Graded on the modified Davis scale · 45-degree field of view:
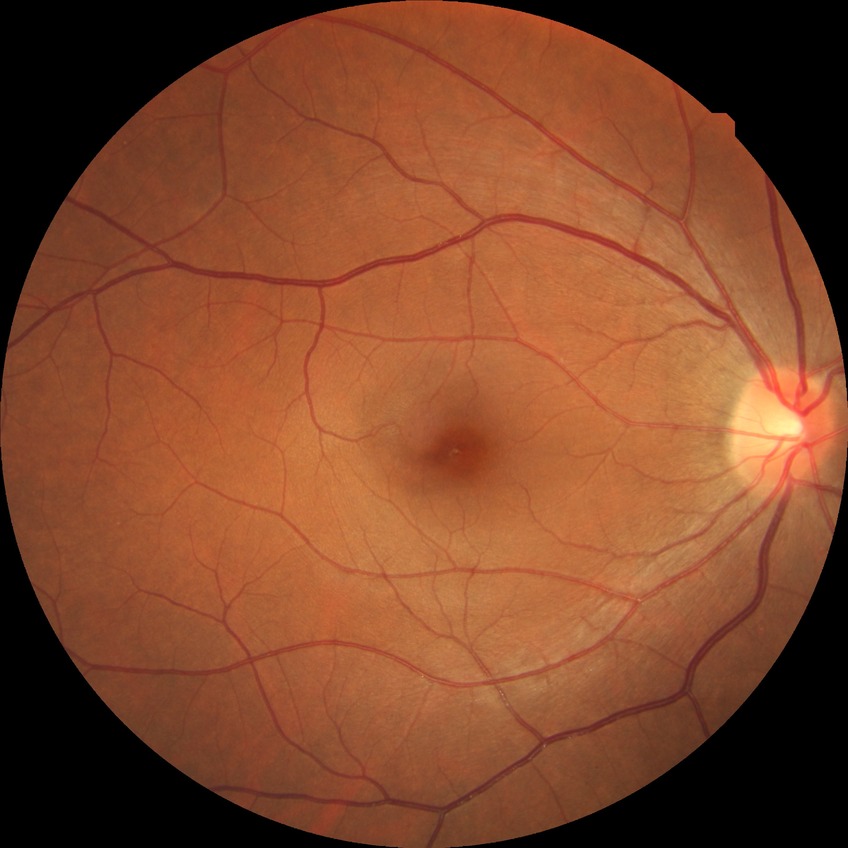

Retinopathy grade: no diabetic retinopathy.